45° FOV. 2352x1568px: 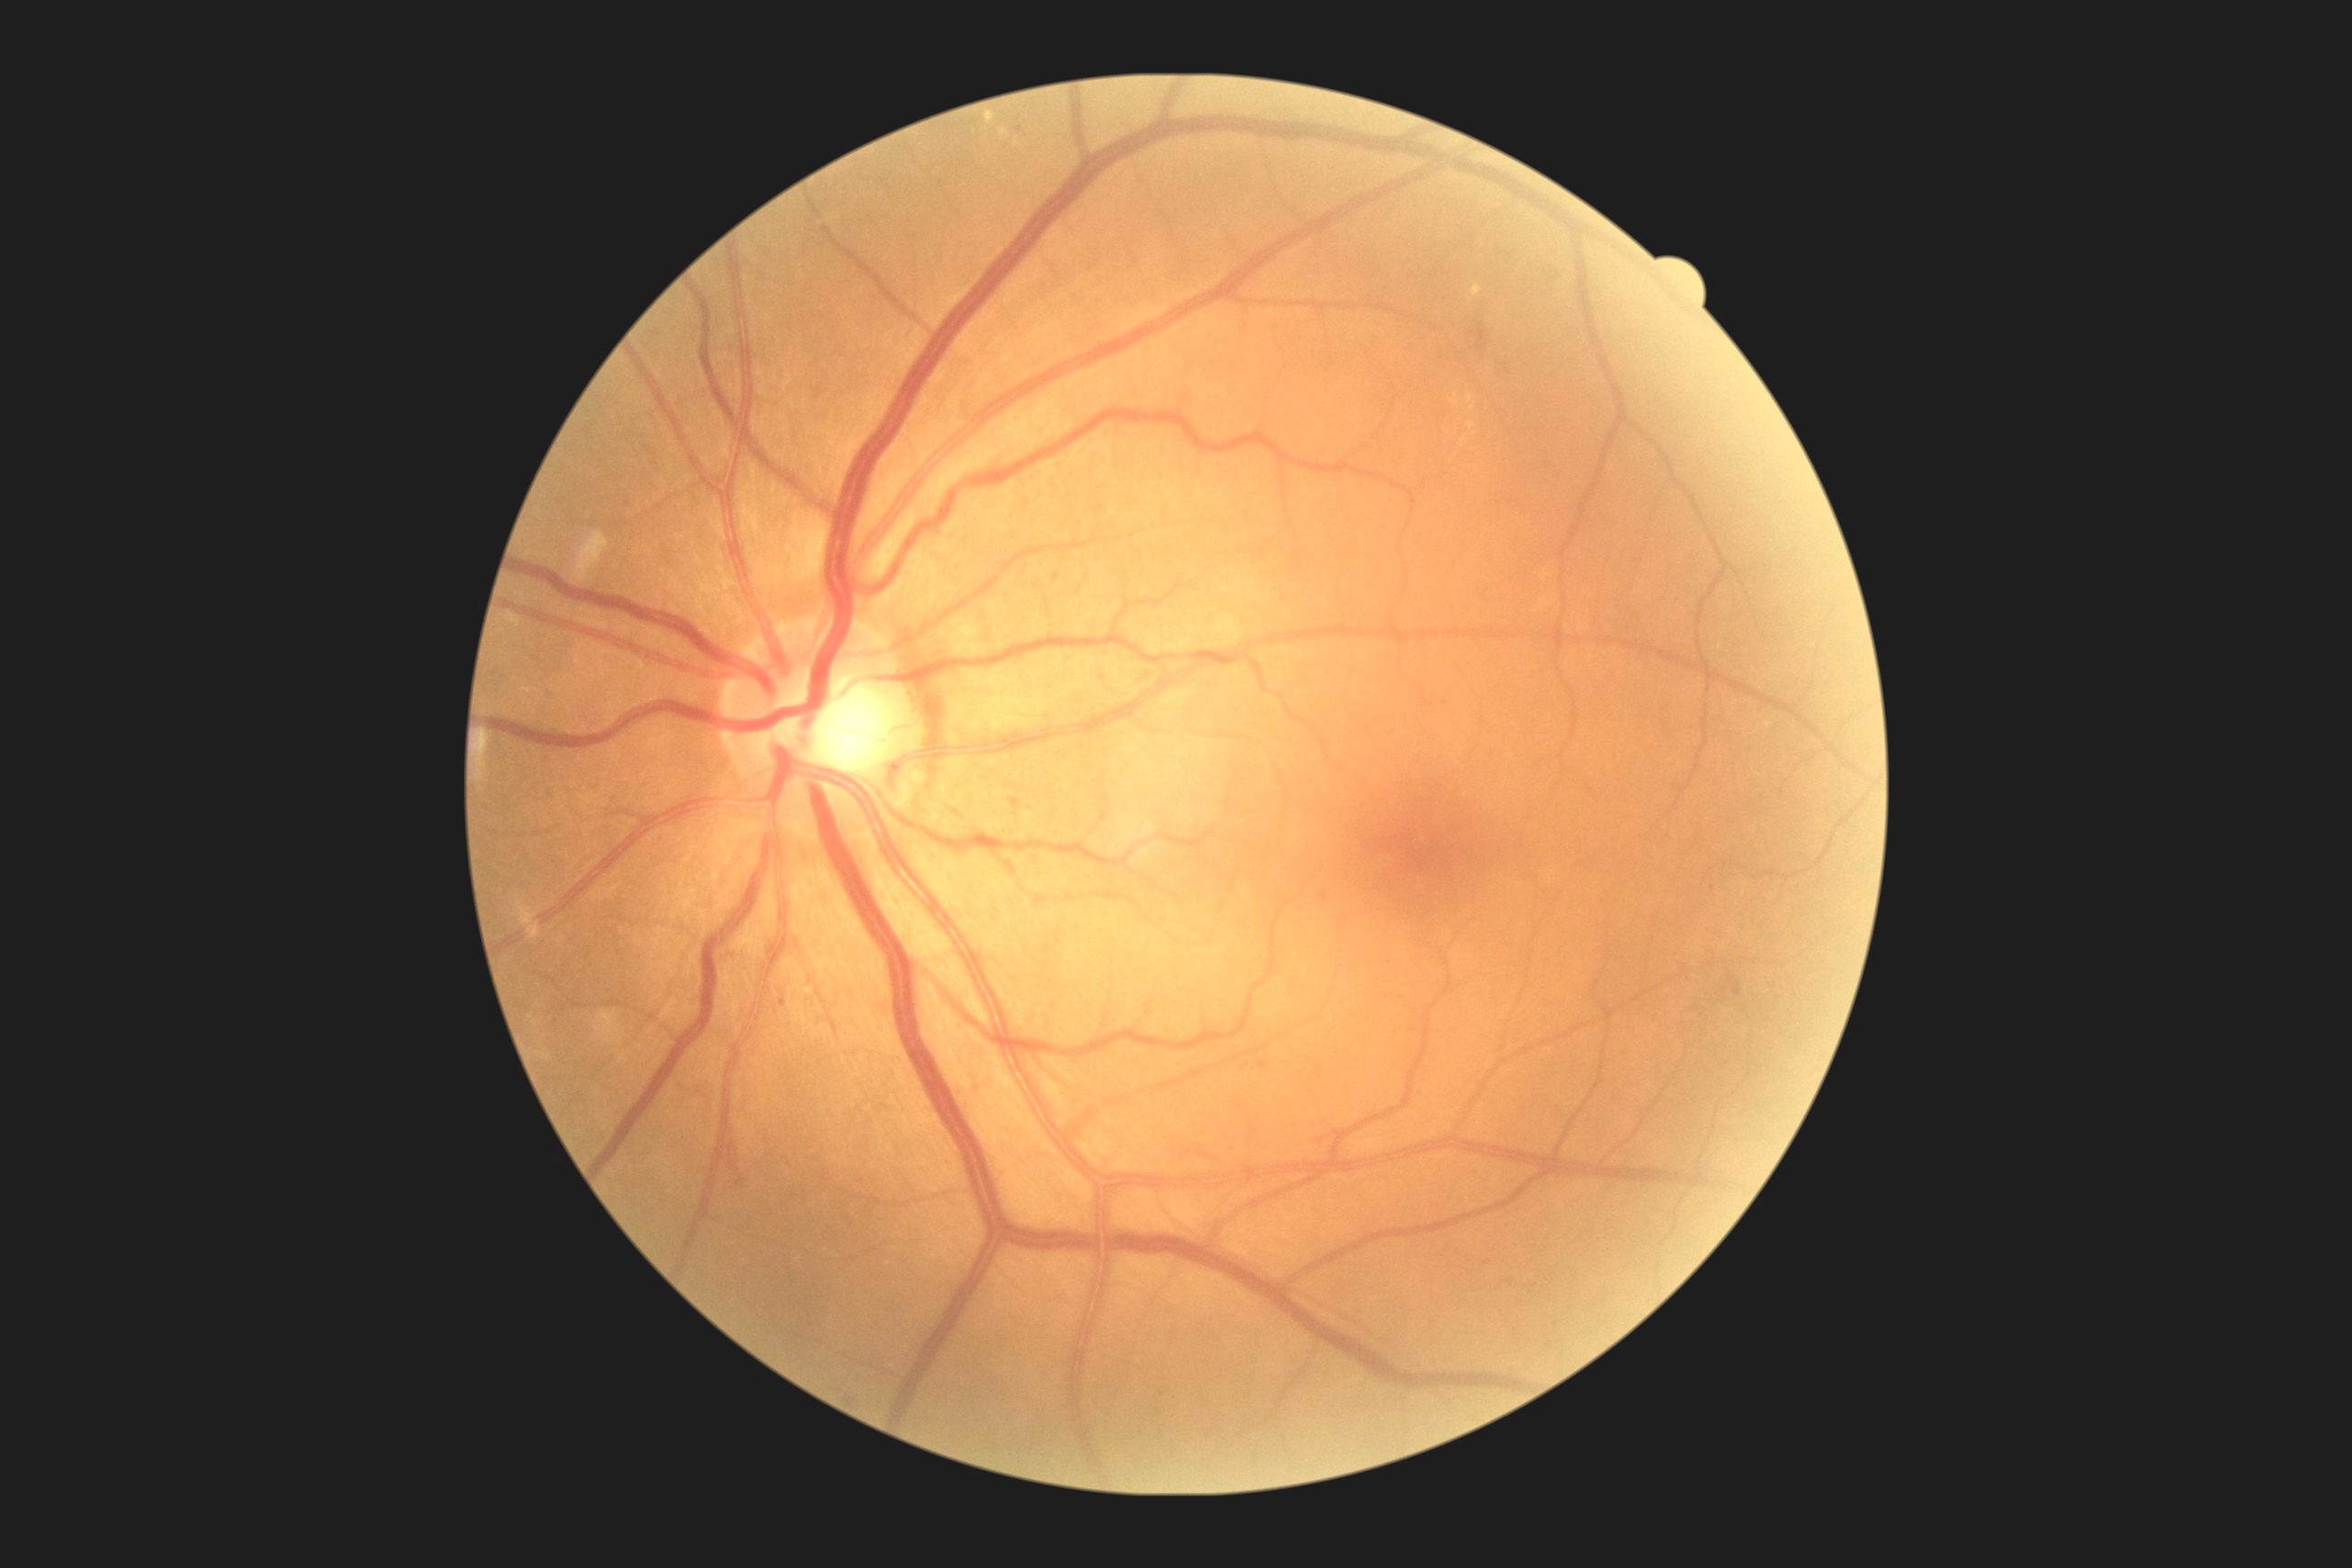 Findings:
- DR severity — grade 2 (moderate NPDR)